45-degree field of view. No pharmacologic dilation. Posterior pole color fundus photograph. NIDEK AFC-230 fundus camera:
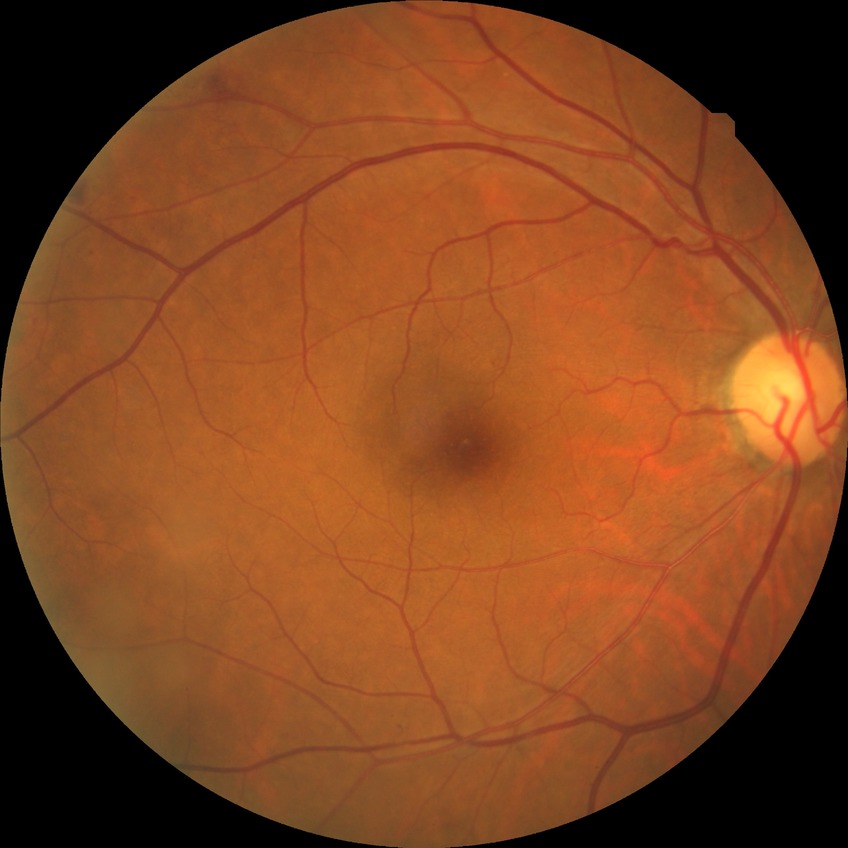
Modified Davis grade: SDR. Disease class: non-proliferative diabetic retinopathy.